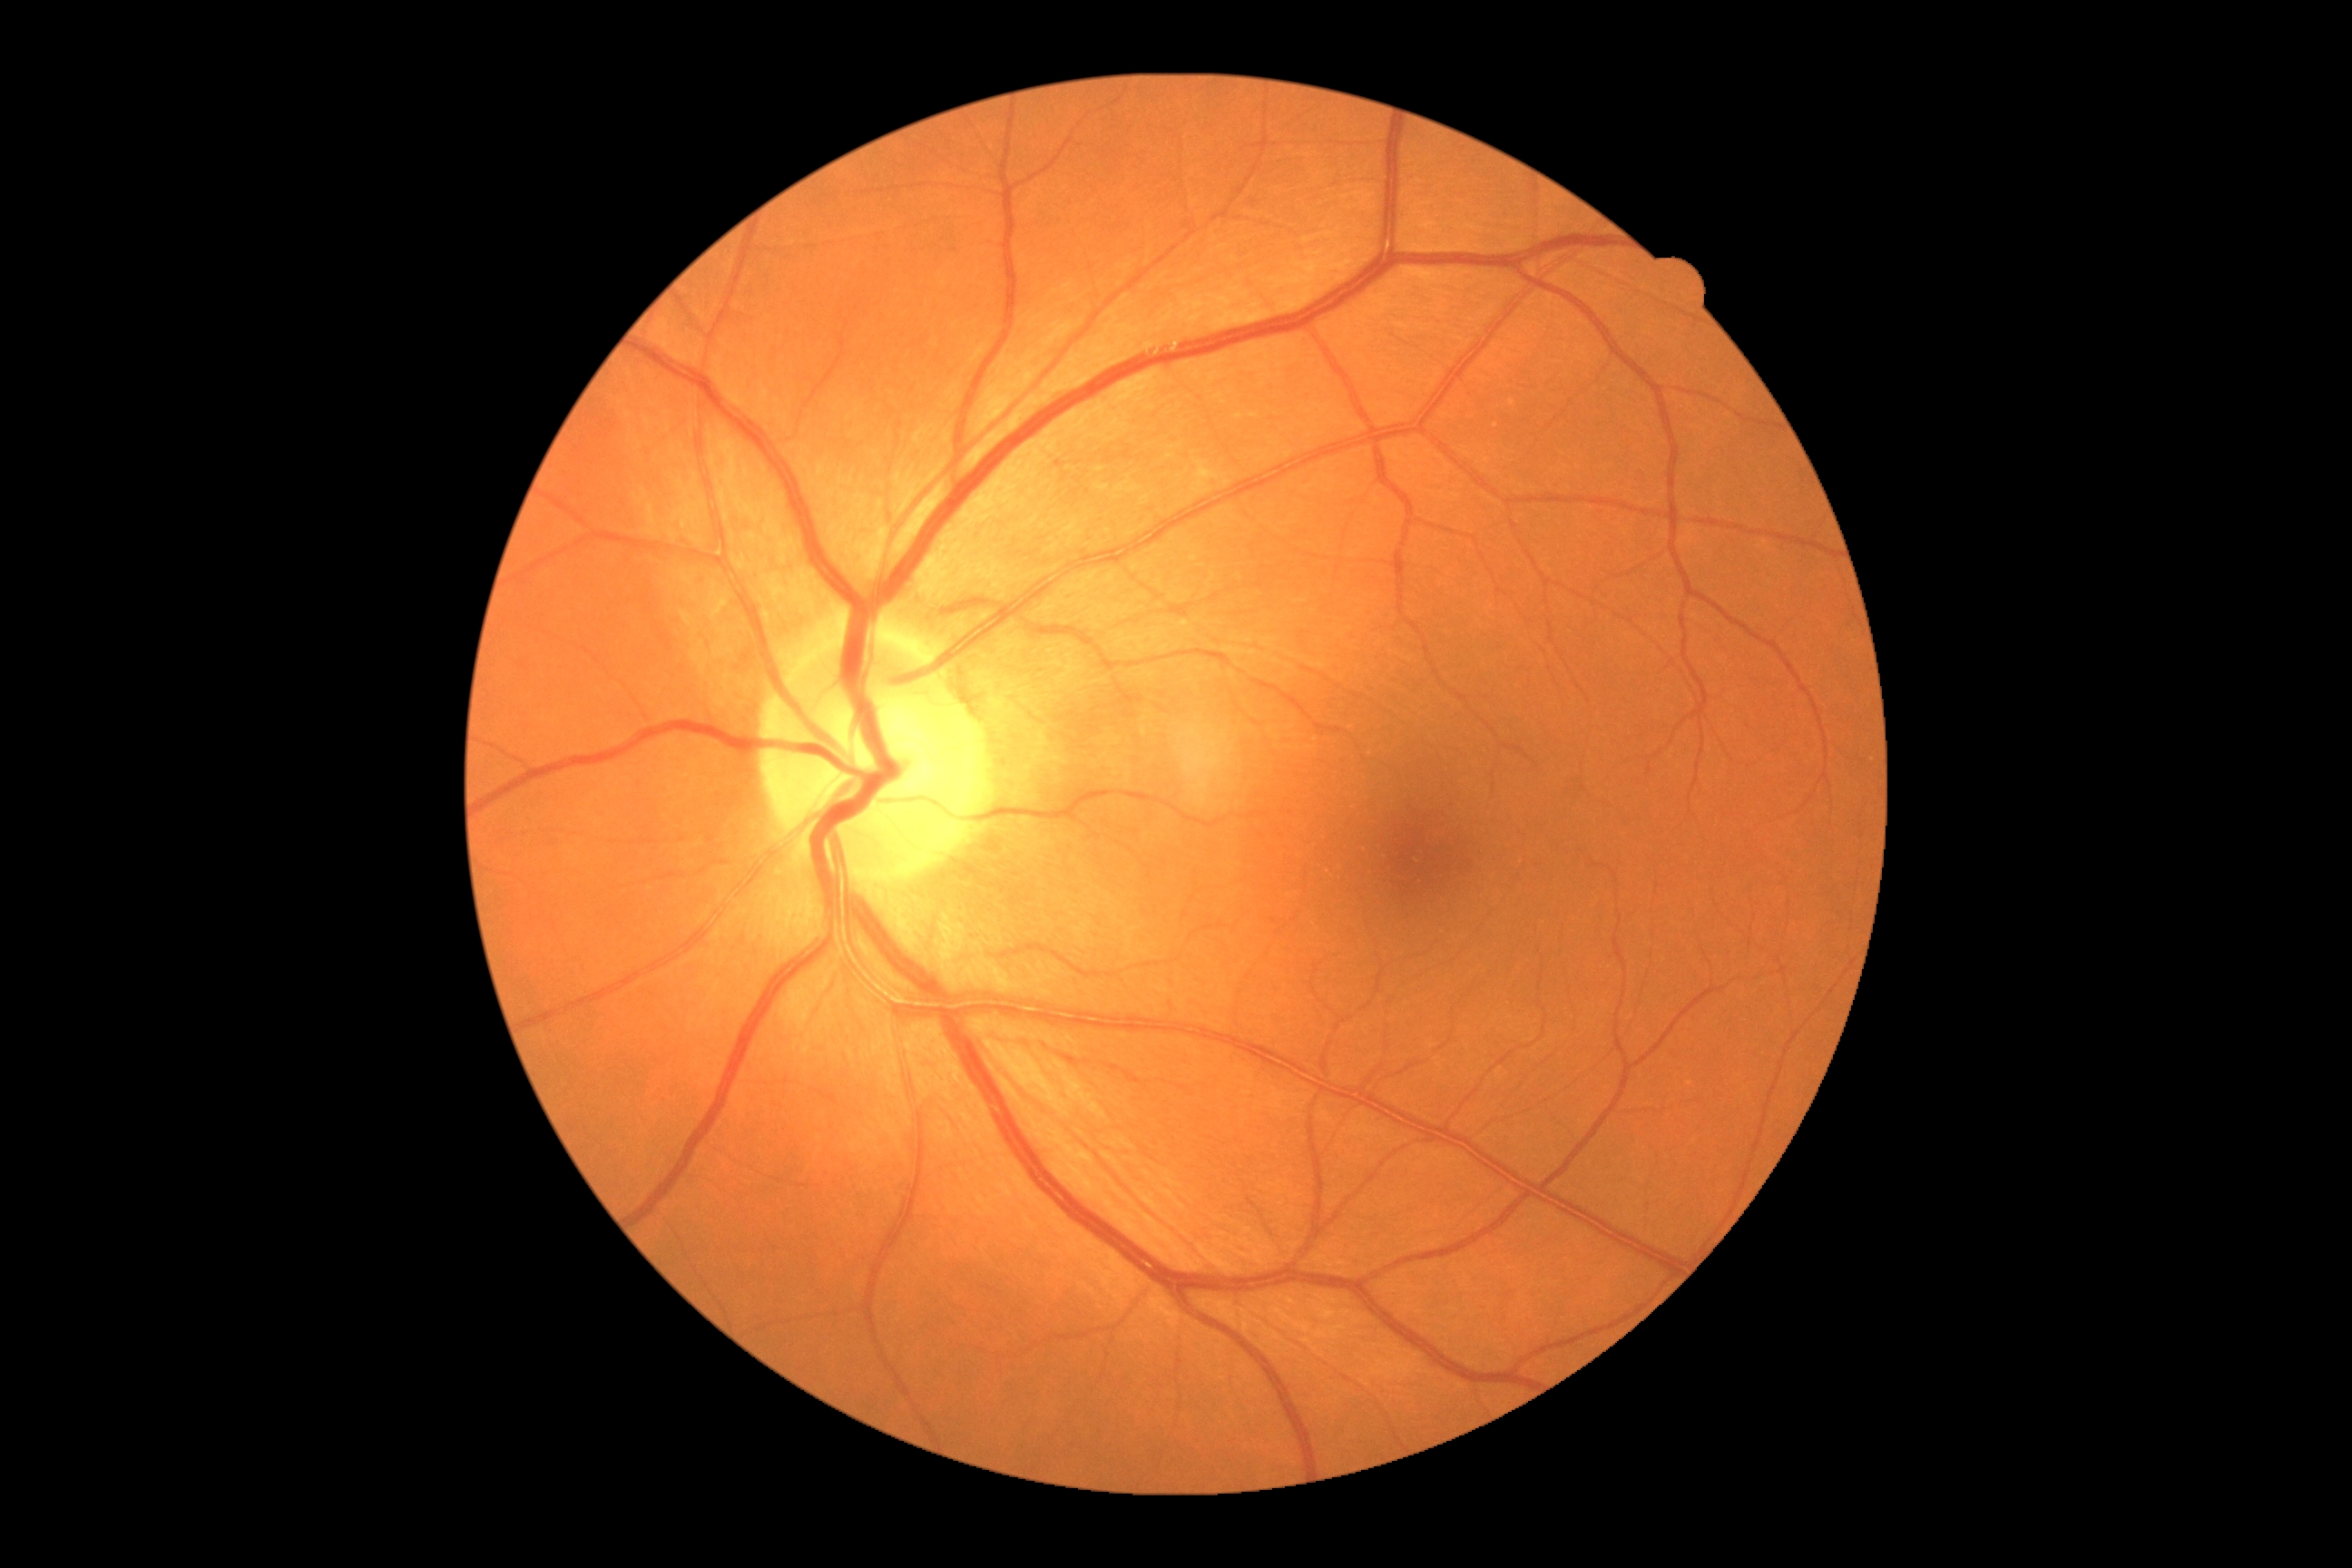
Diabetic retinopathy severity: no apparent retinopathy (grade 0).